2352x1568px: 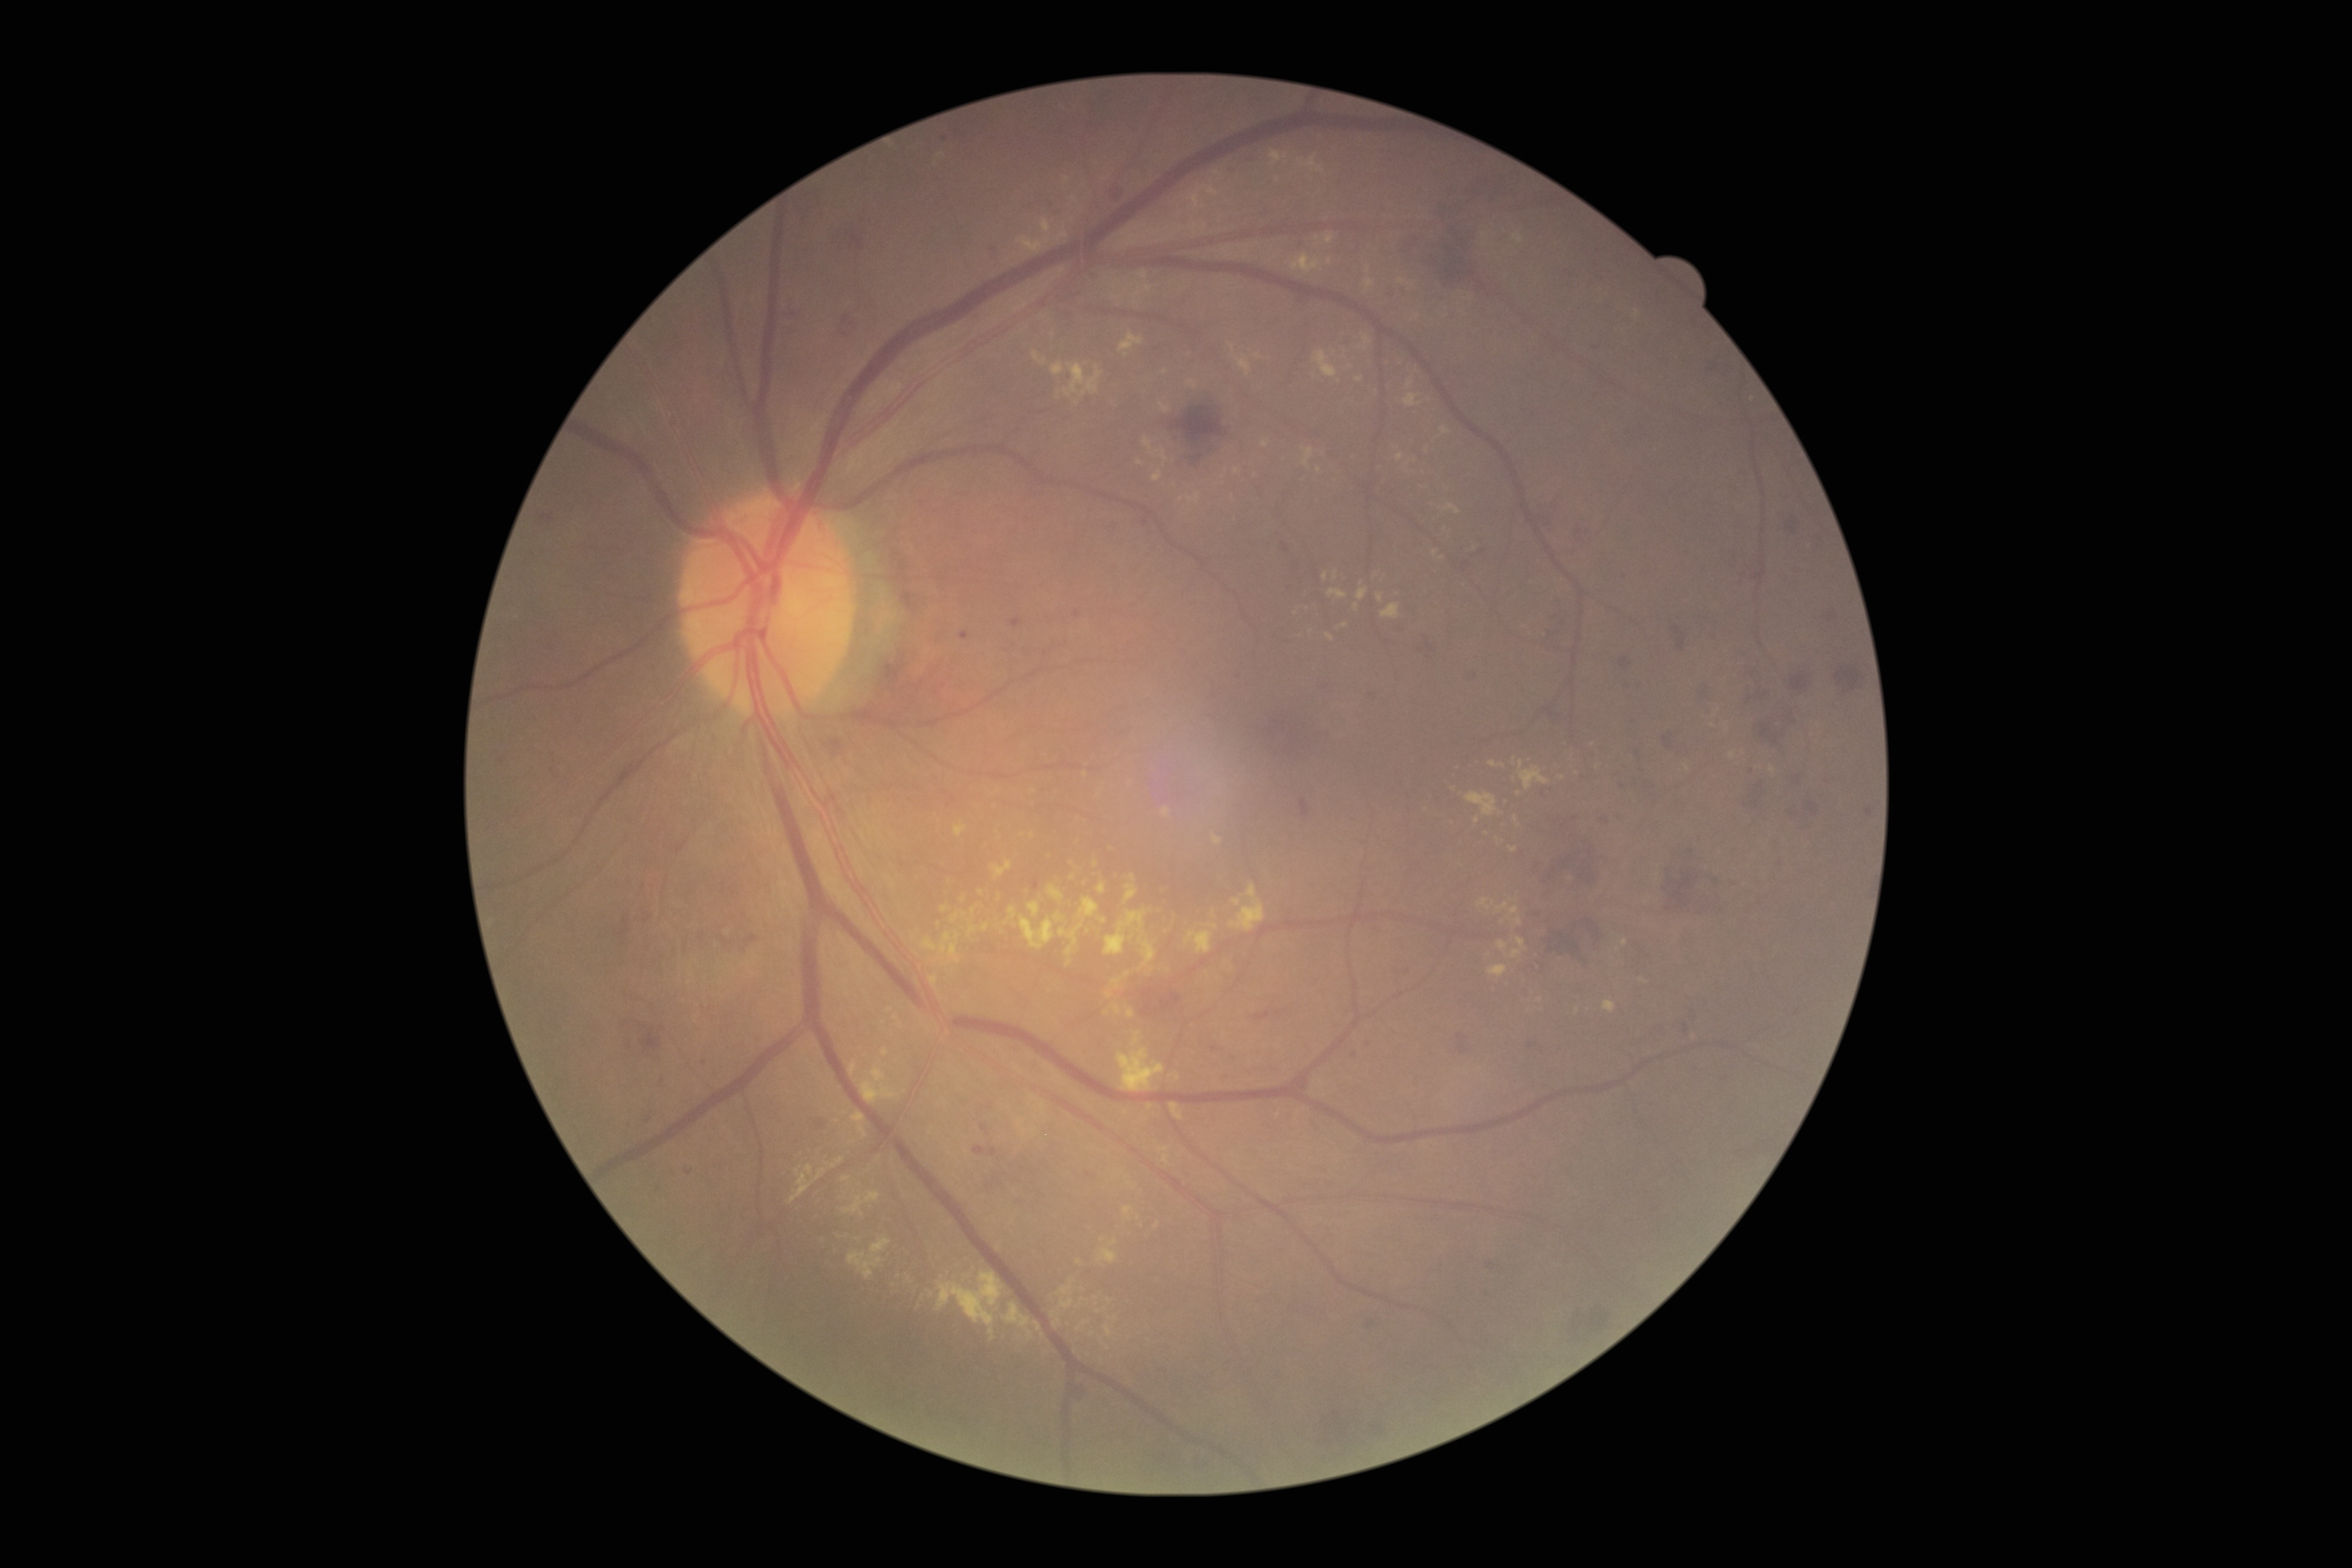 Diabetic retinopathy severity: moderate non-proliferative diabetic retinopathy (grade 2)
Selected lesions:
hard exudates (partial): x1=1143, y1=437, x2=1169, y2=463; x1=1404, y1=394, x2=1422, y2=407; x1=788, y1=1165, x2=827, y2=1203; x1=941, y1=906, x2=950, y2=913; x1=1187, y1=381, x2=1198, y2=389; x1=1111, y1=1005, x2=1121, y2=1016; x1=1041, y1=218, x2=1052, y2=234; x1=1123, y1=1206, x2=1134, y2=1218; x1=1079, y1=897, x2=1099, y2=918; x1=1261, y1=441, x2=1269, y2=447
Small hard exudates near [1109,1300]; [1727,725]; [1528,761]; [1502,923]; [1166,373]; [896,1016]; [1435,552]; [910,1280]